Remidio Fundus on Phone (FOP) camera · color fundus photograph · image size 1659x2212
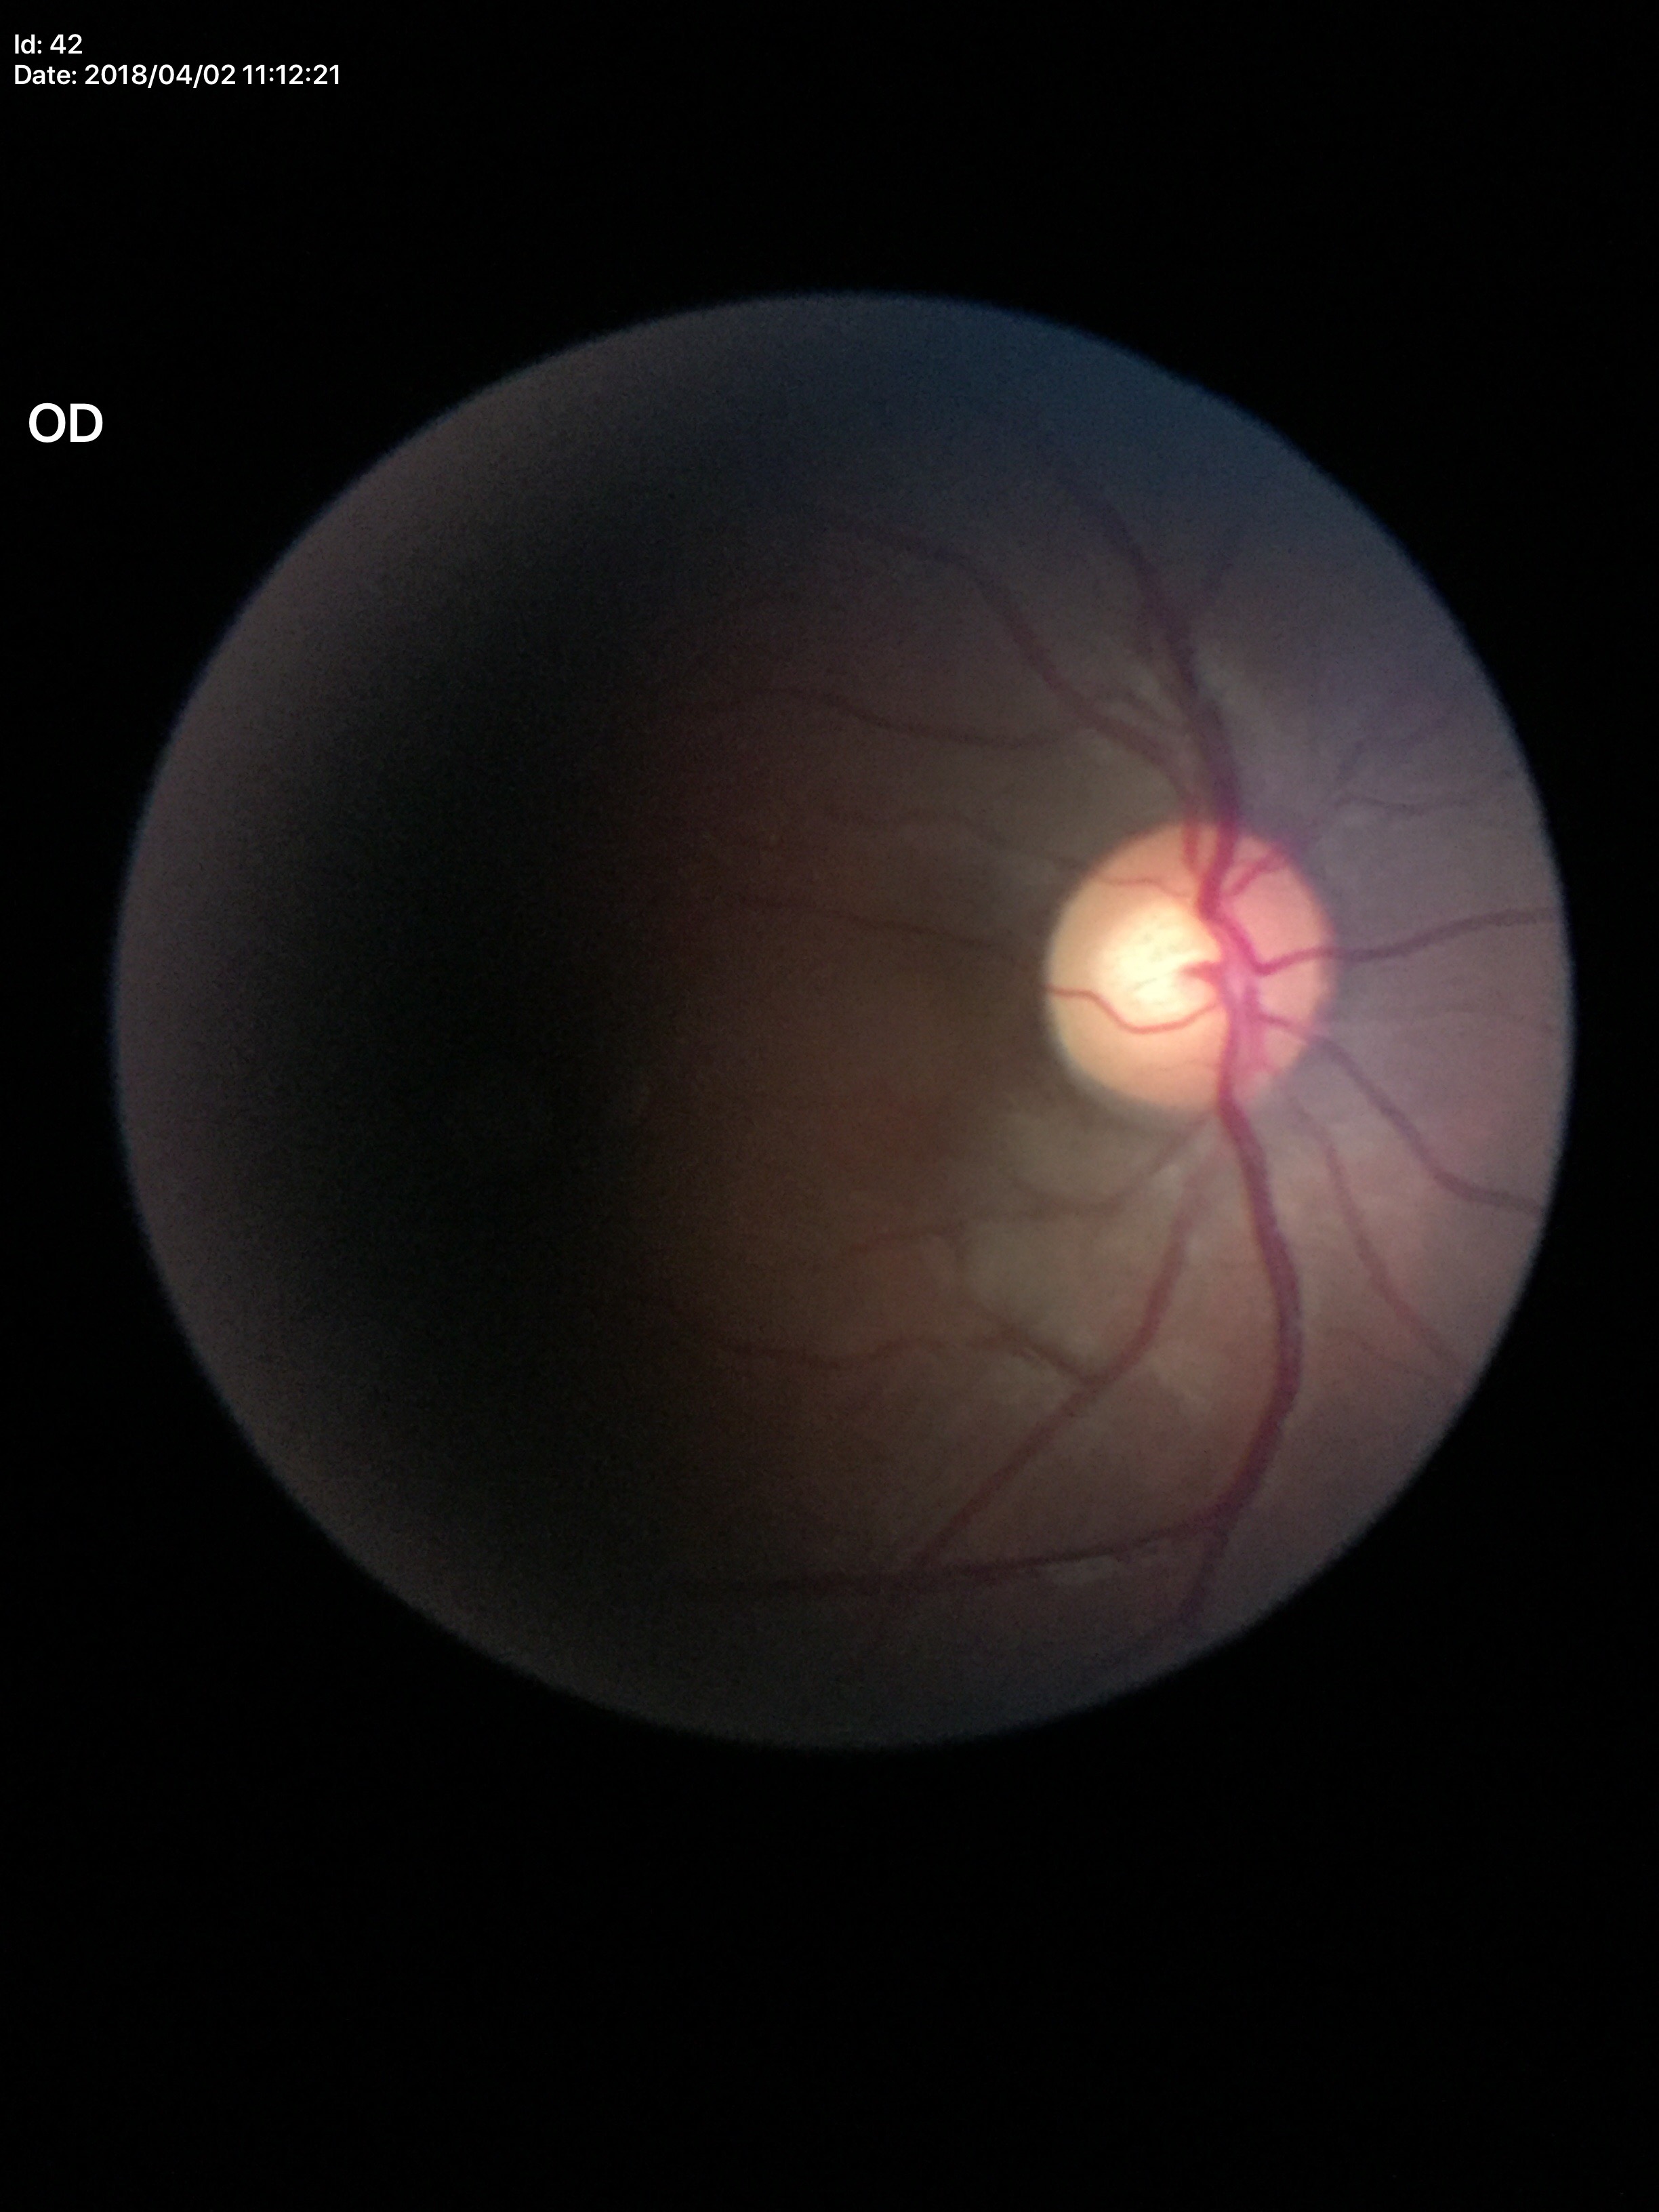
{"glaucoma_decision": "negative (1 of 5 graders flagged glaucoma suspect)", "vcdr": "0.56", "acdr": "0.34"}